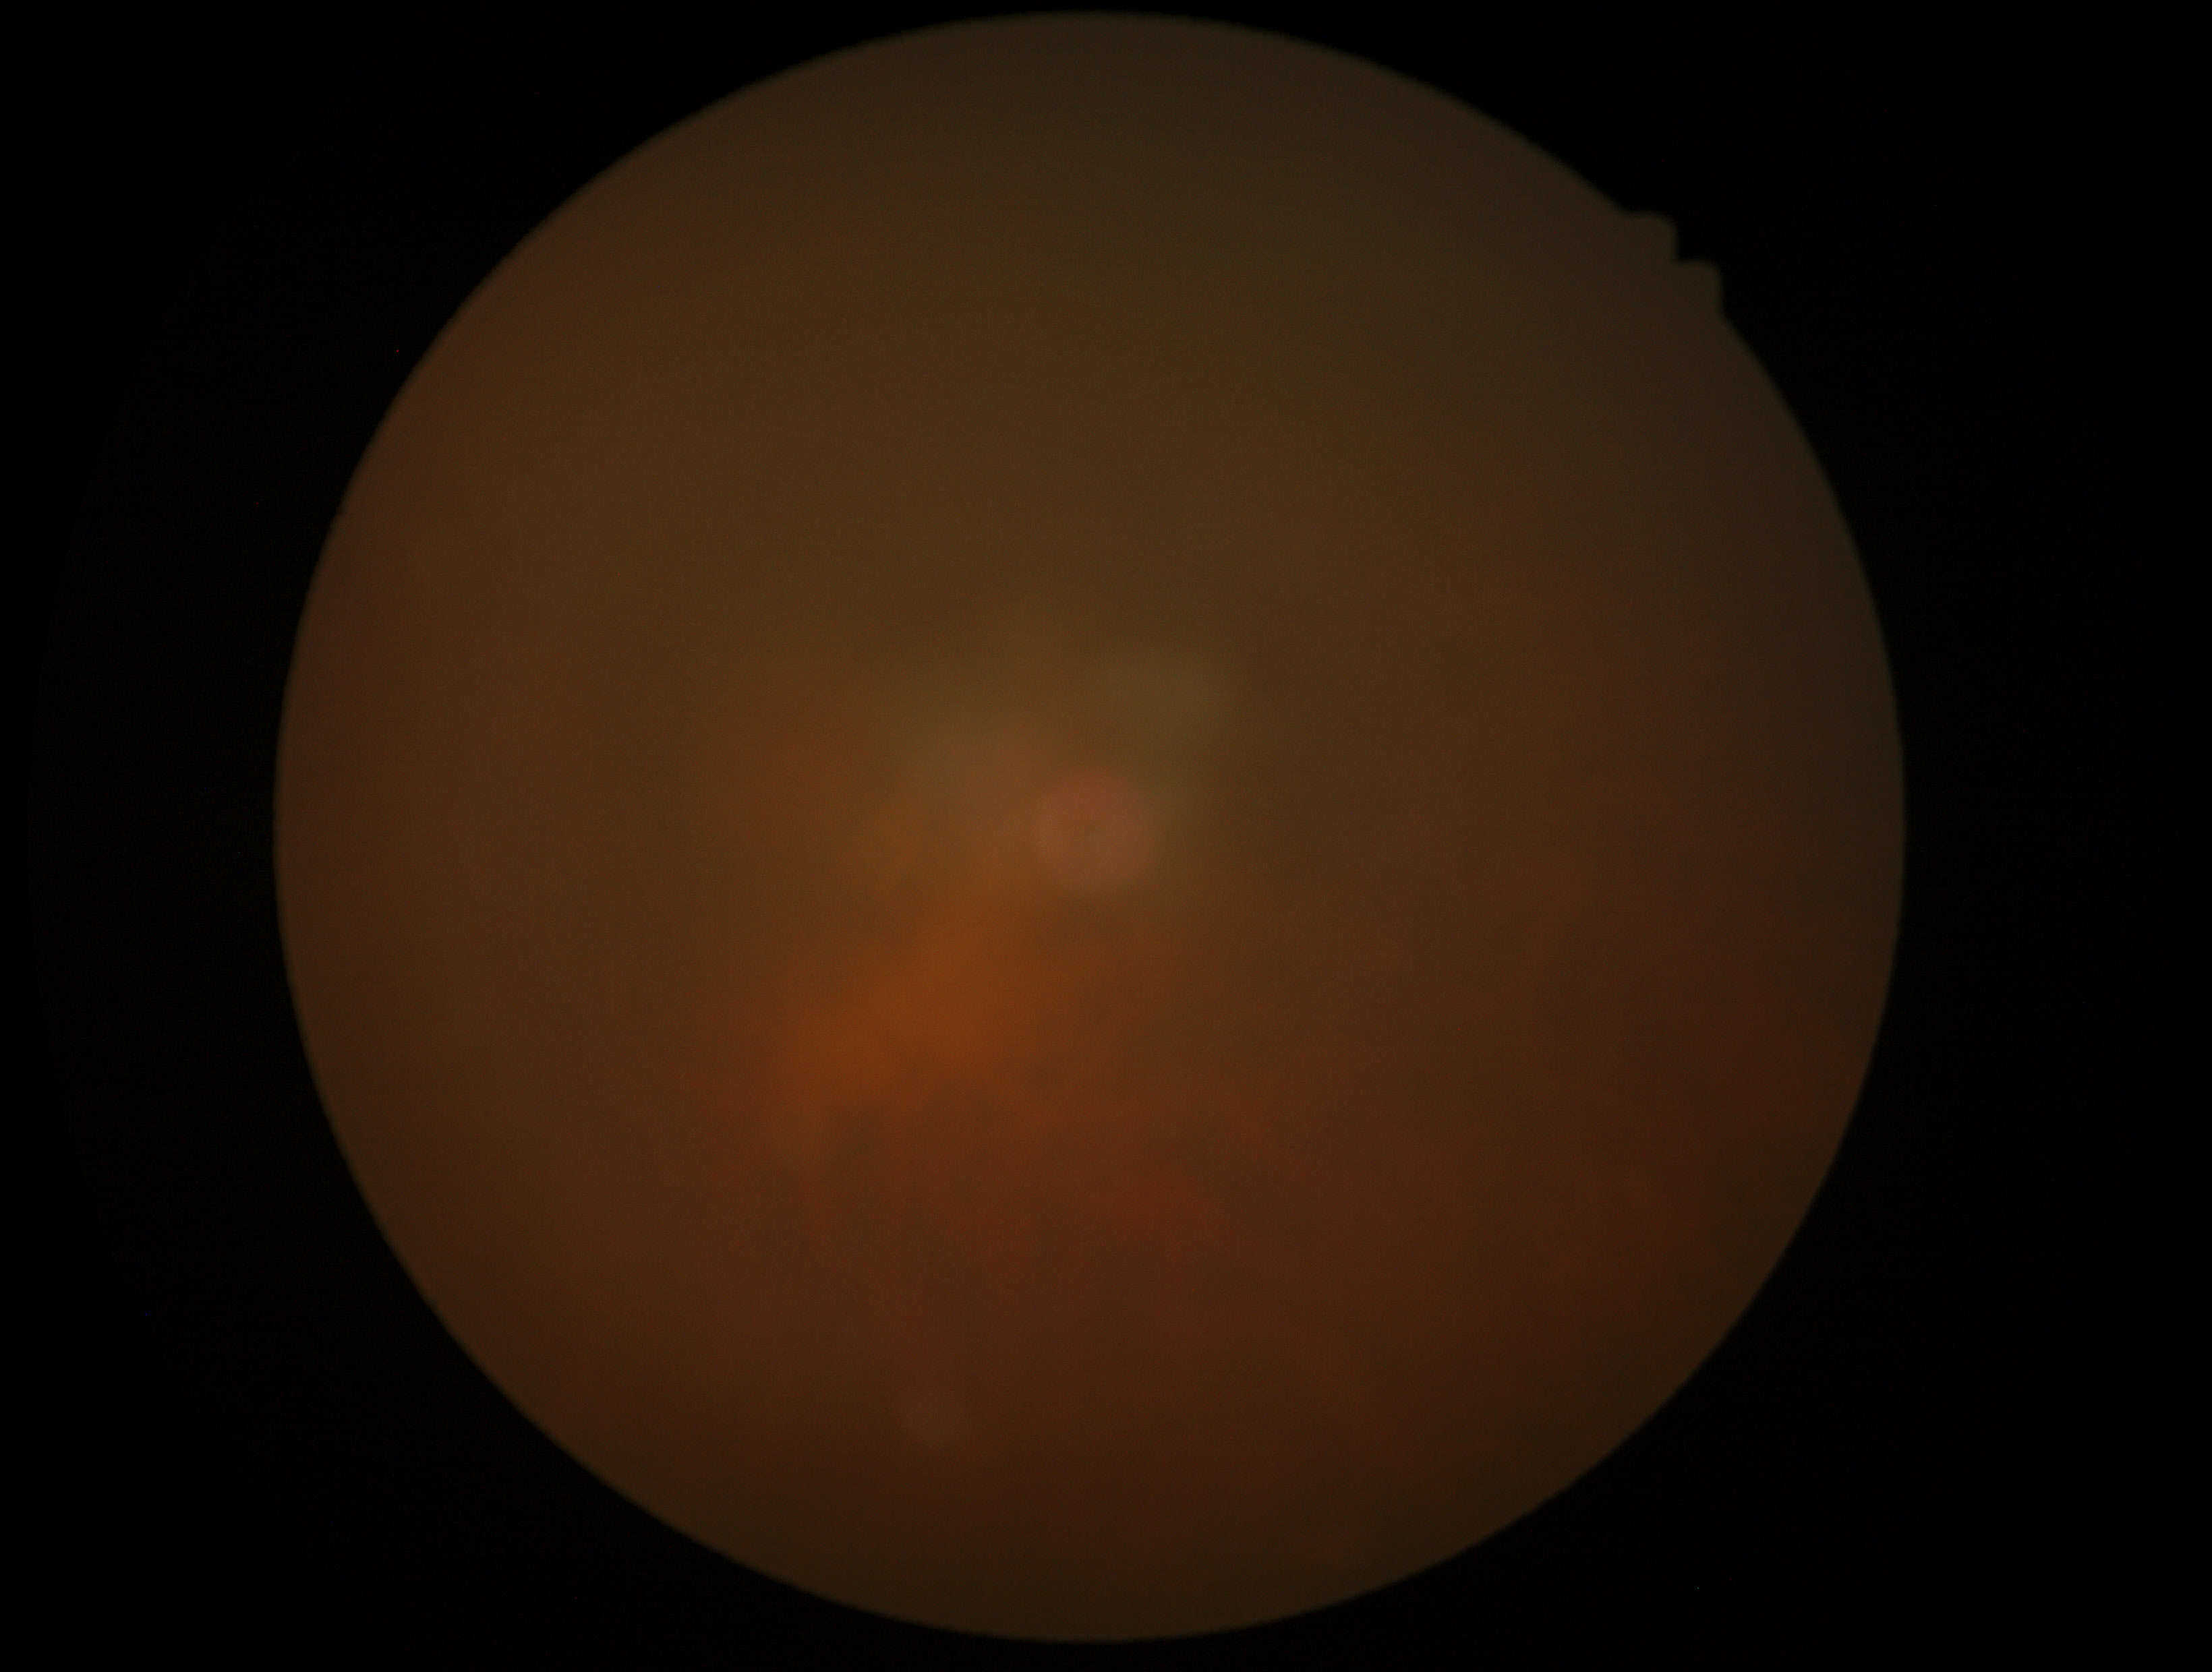 Annotations:
* DR grade: ungradable due to poor image quality